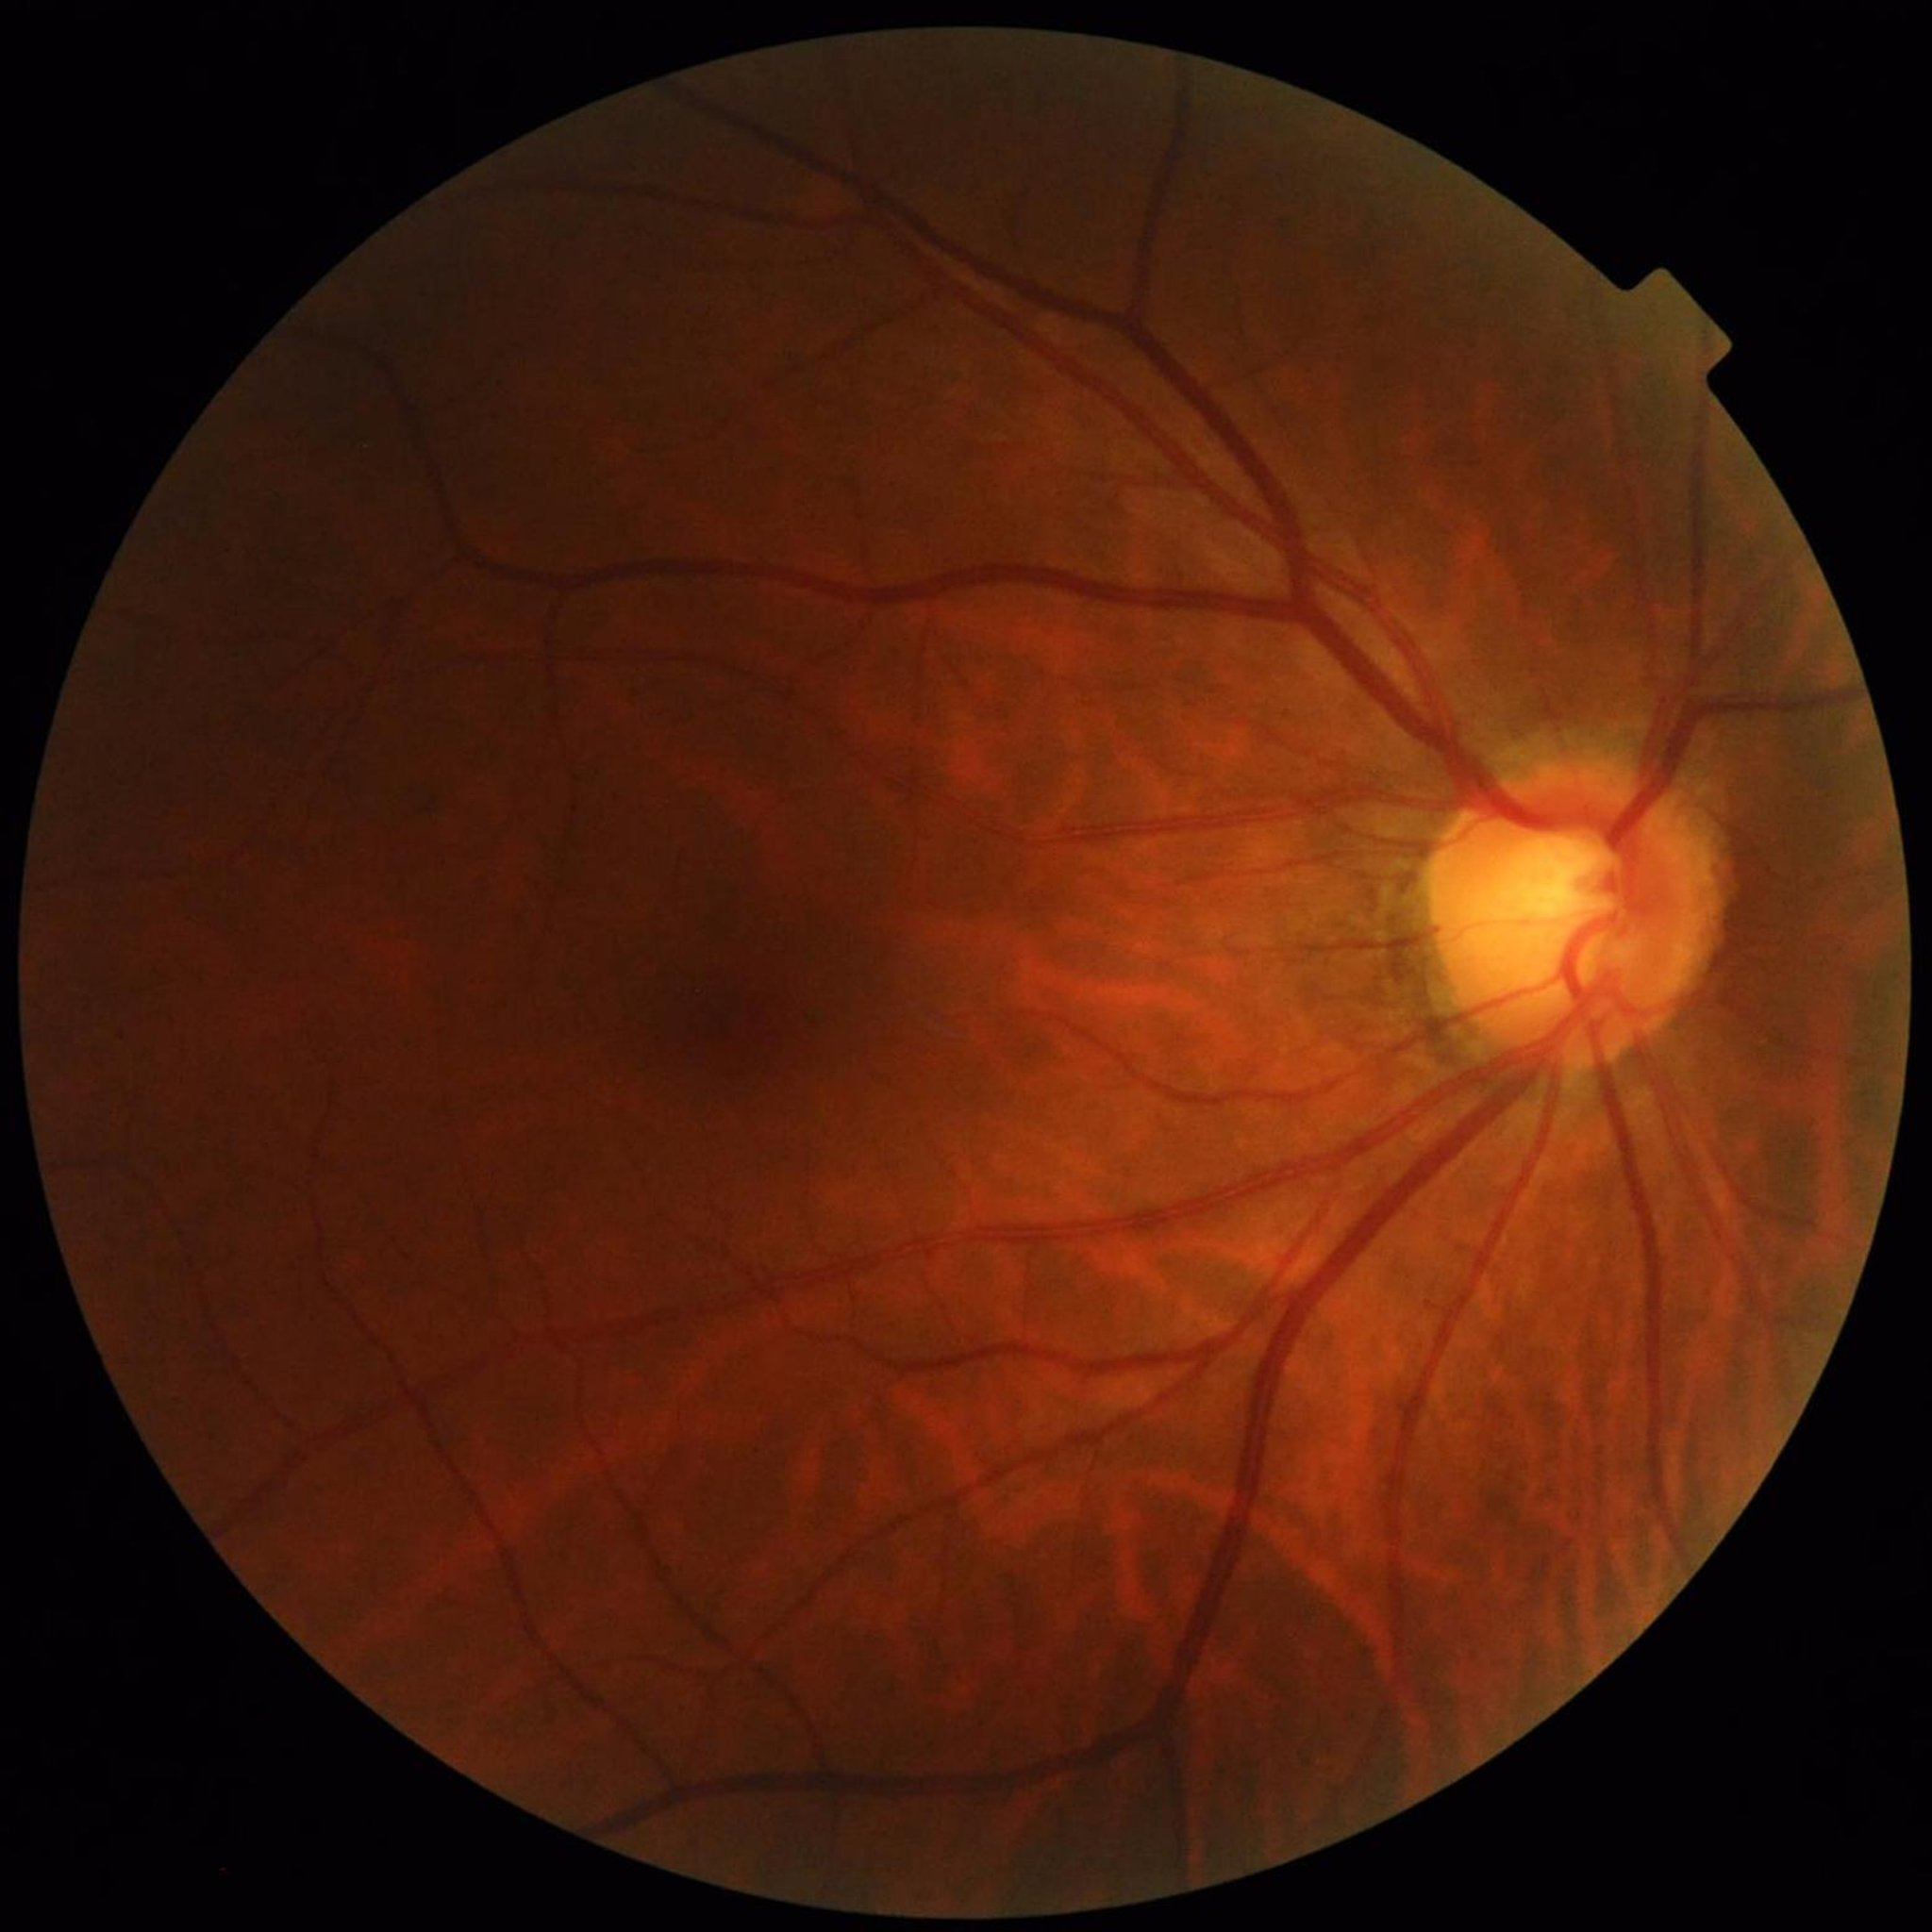
diagnosis: glaucoma